Graded on the modified Davis scale — 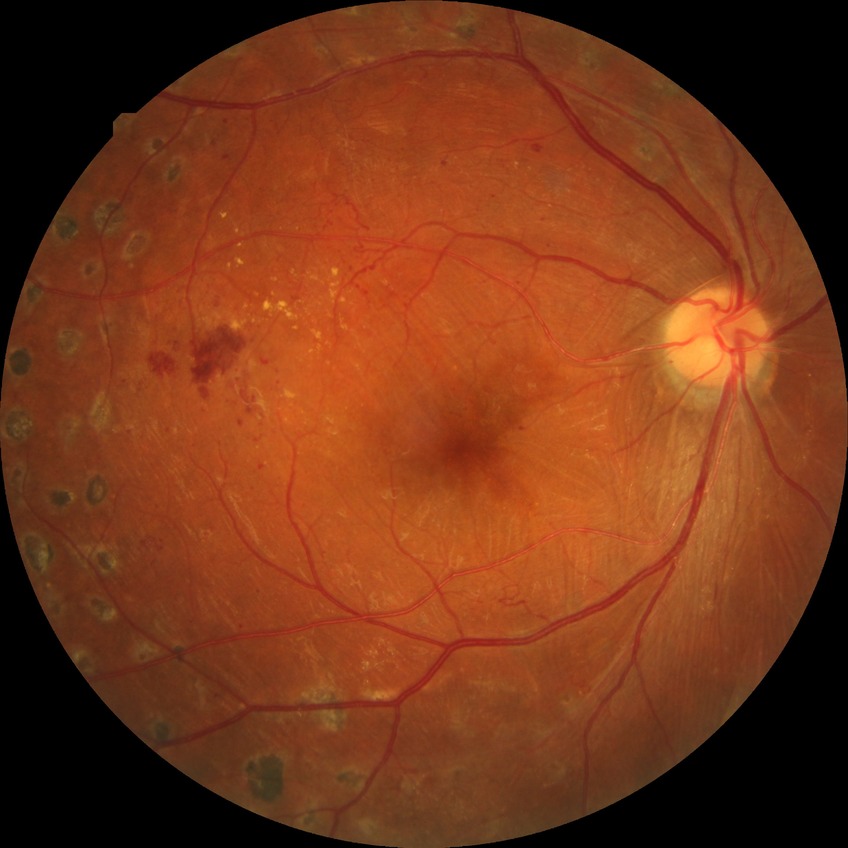
Diabetic retinopathy (DR) is proliferative diabetic retinopathy (PDR).